Clarity RetCam 3, 130° FOV; 640 x 480 pixels; pediatric retinal photograph (wide-field) — 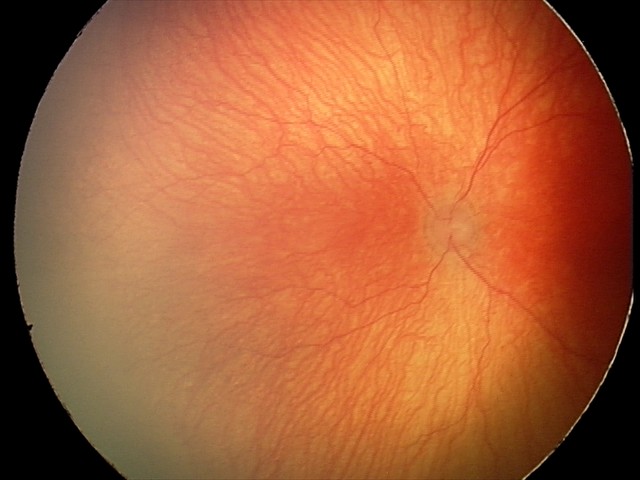
Impression: aggressive retinopathy of prematurity; plus disease — abnormal dilation and tortuosity of the posterior pole retinal vessels.